Image size 640x480; wide-field contact fundus photograph of an infant; acquired on the Clarity RetCam 3:
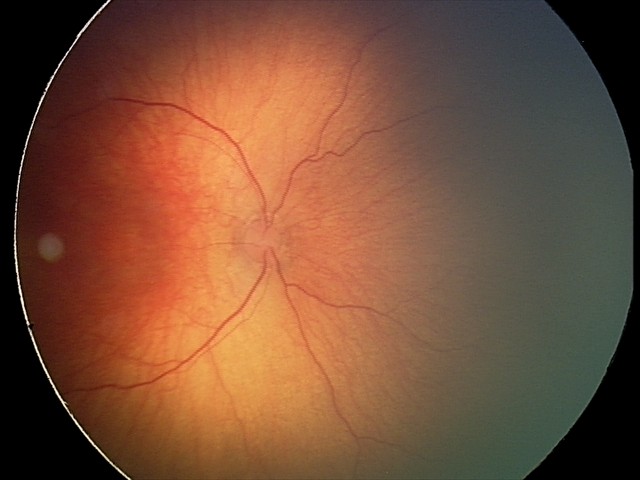 Plus disease absent. Examination diagnosed as status post ROP.